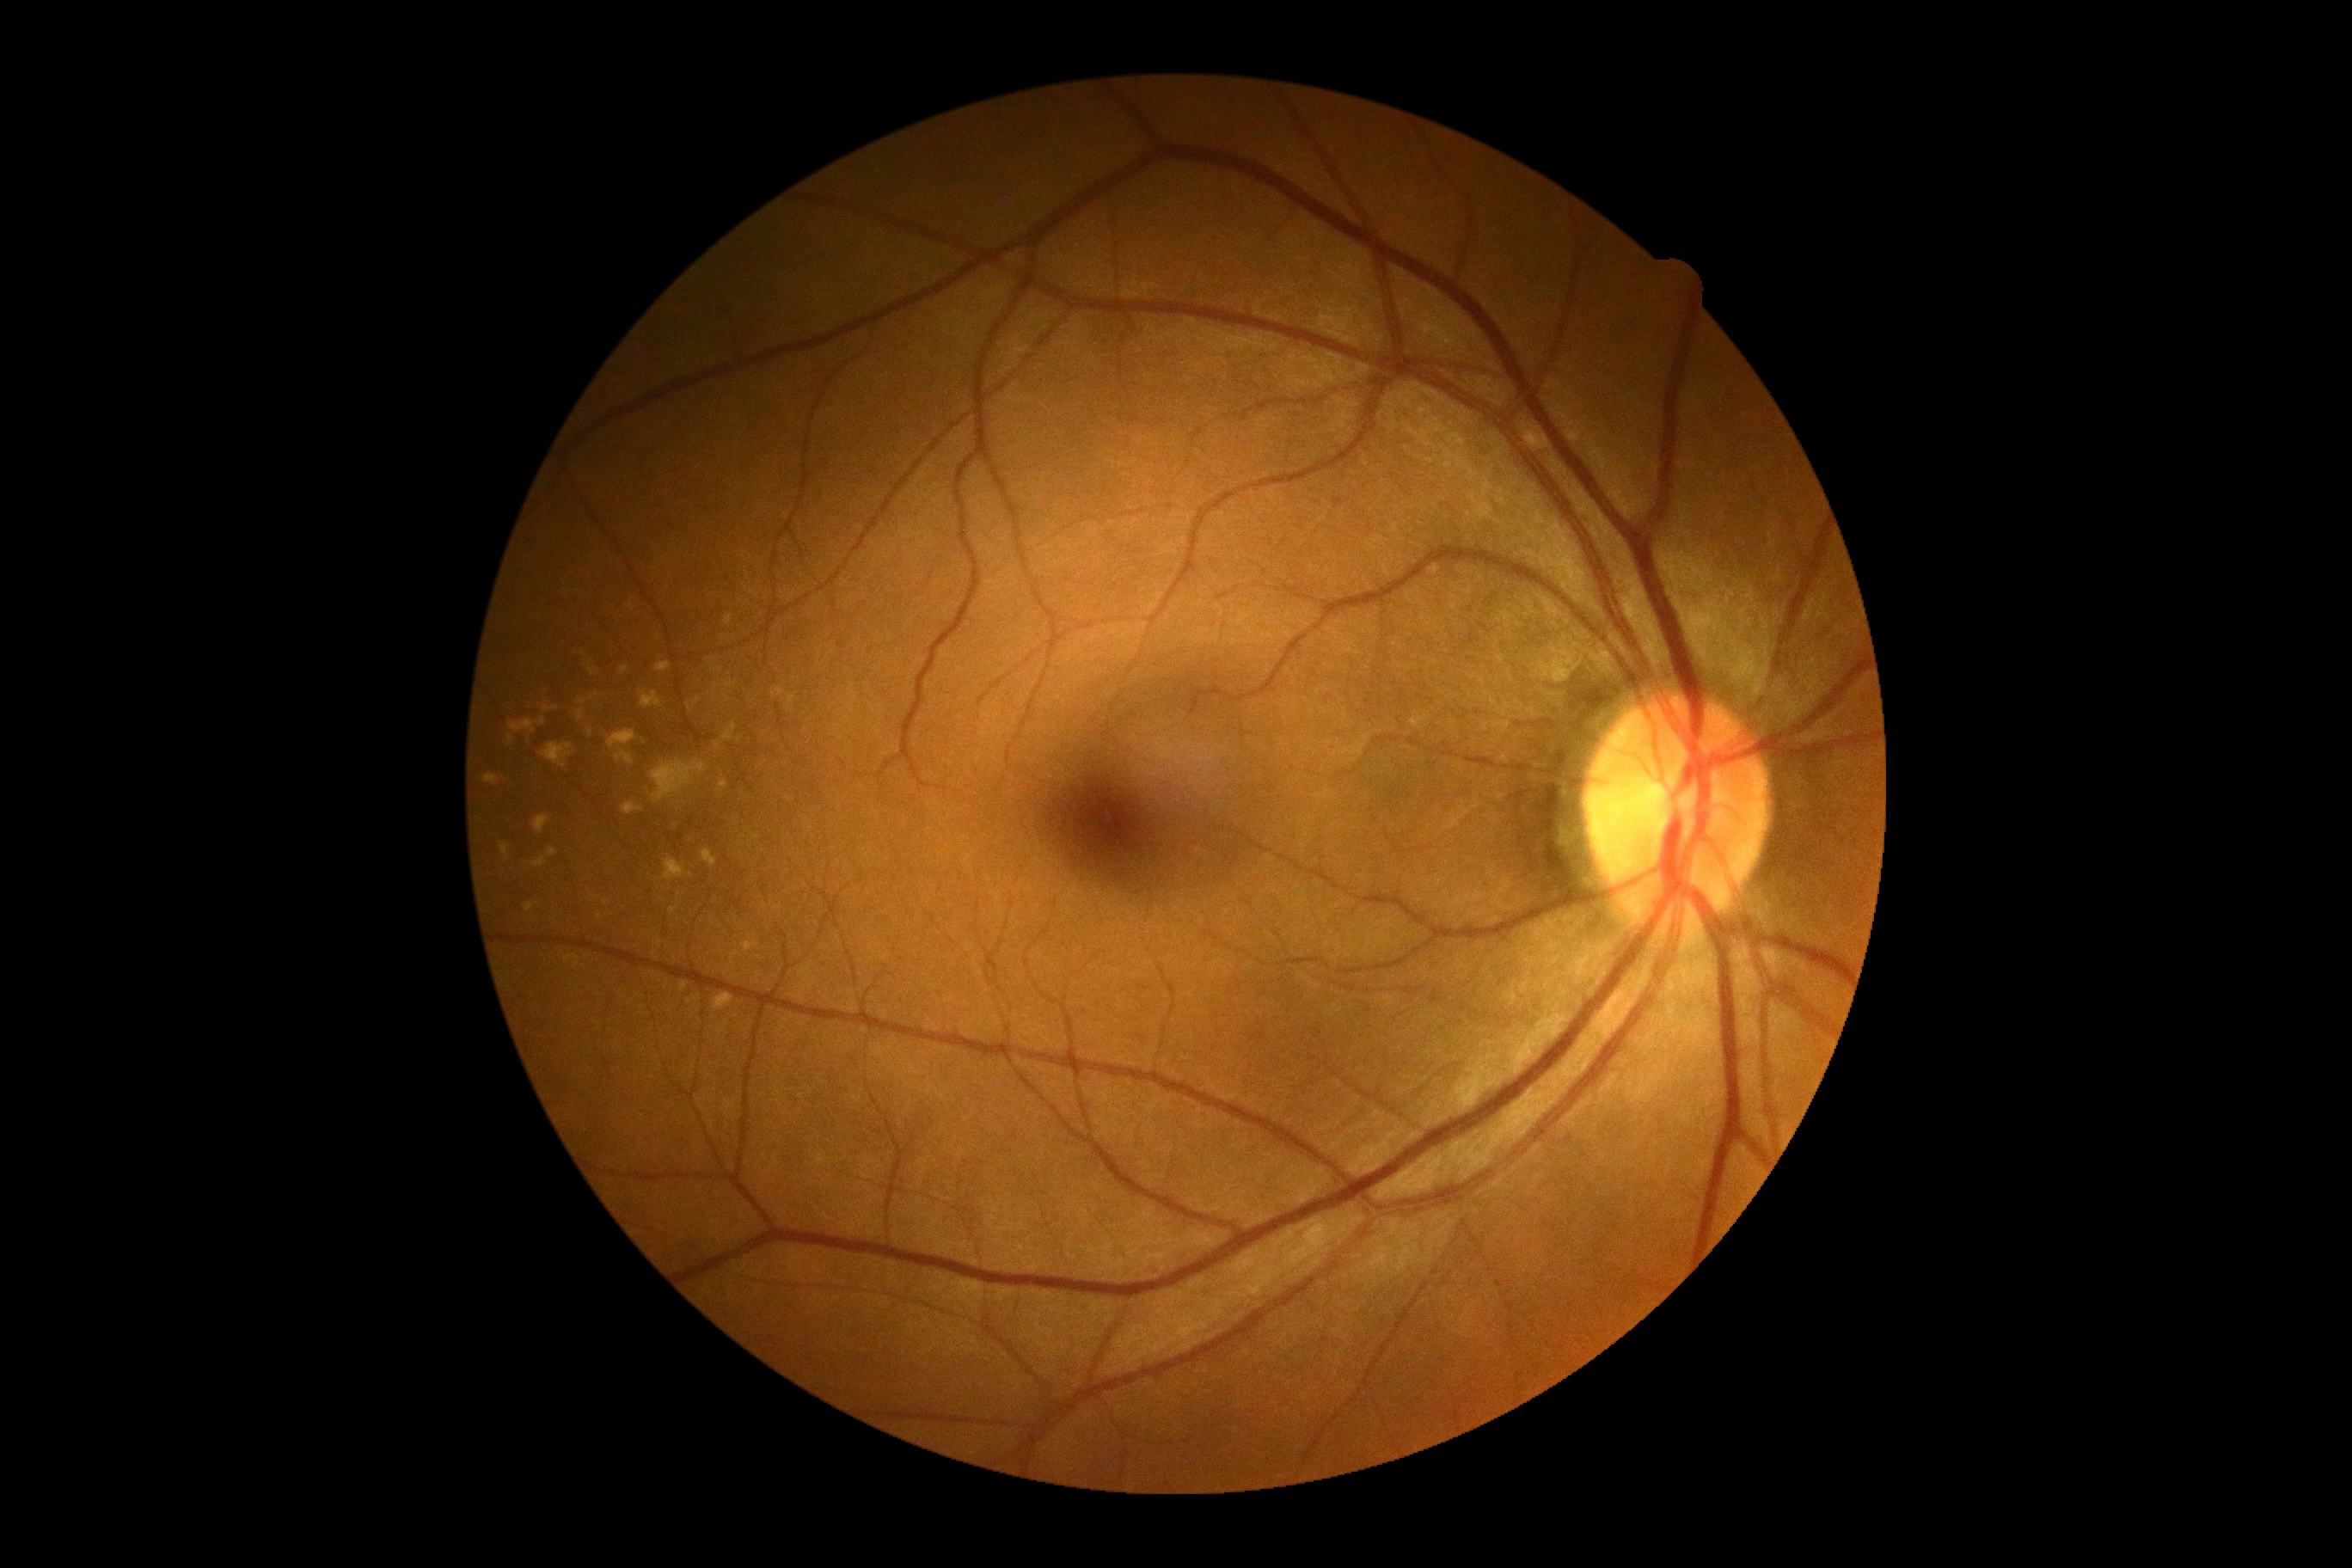

  dr_grade: 0